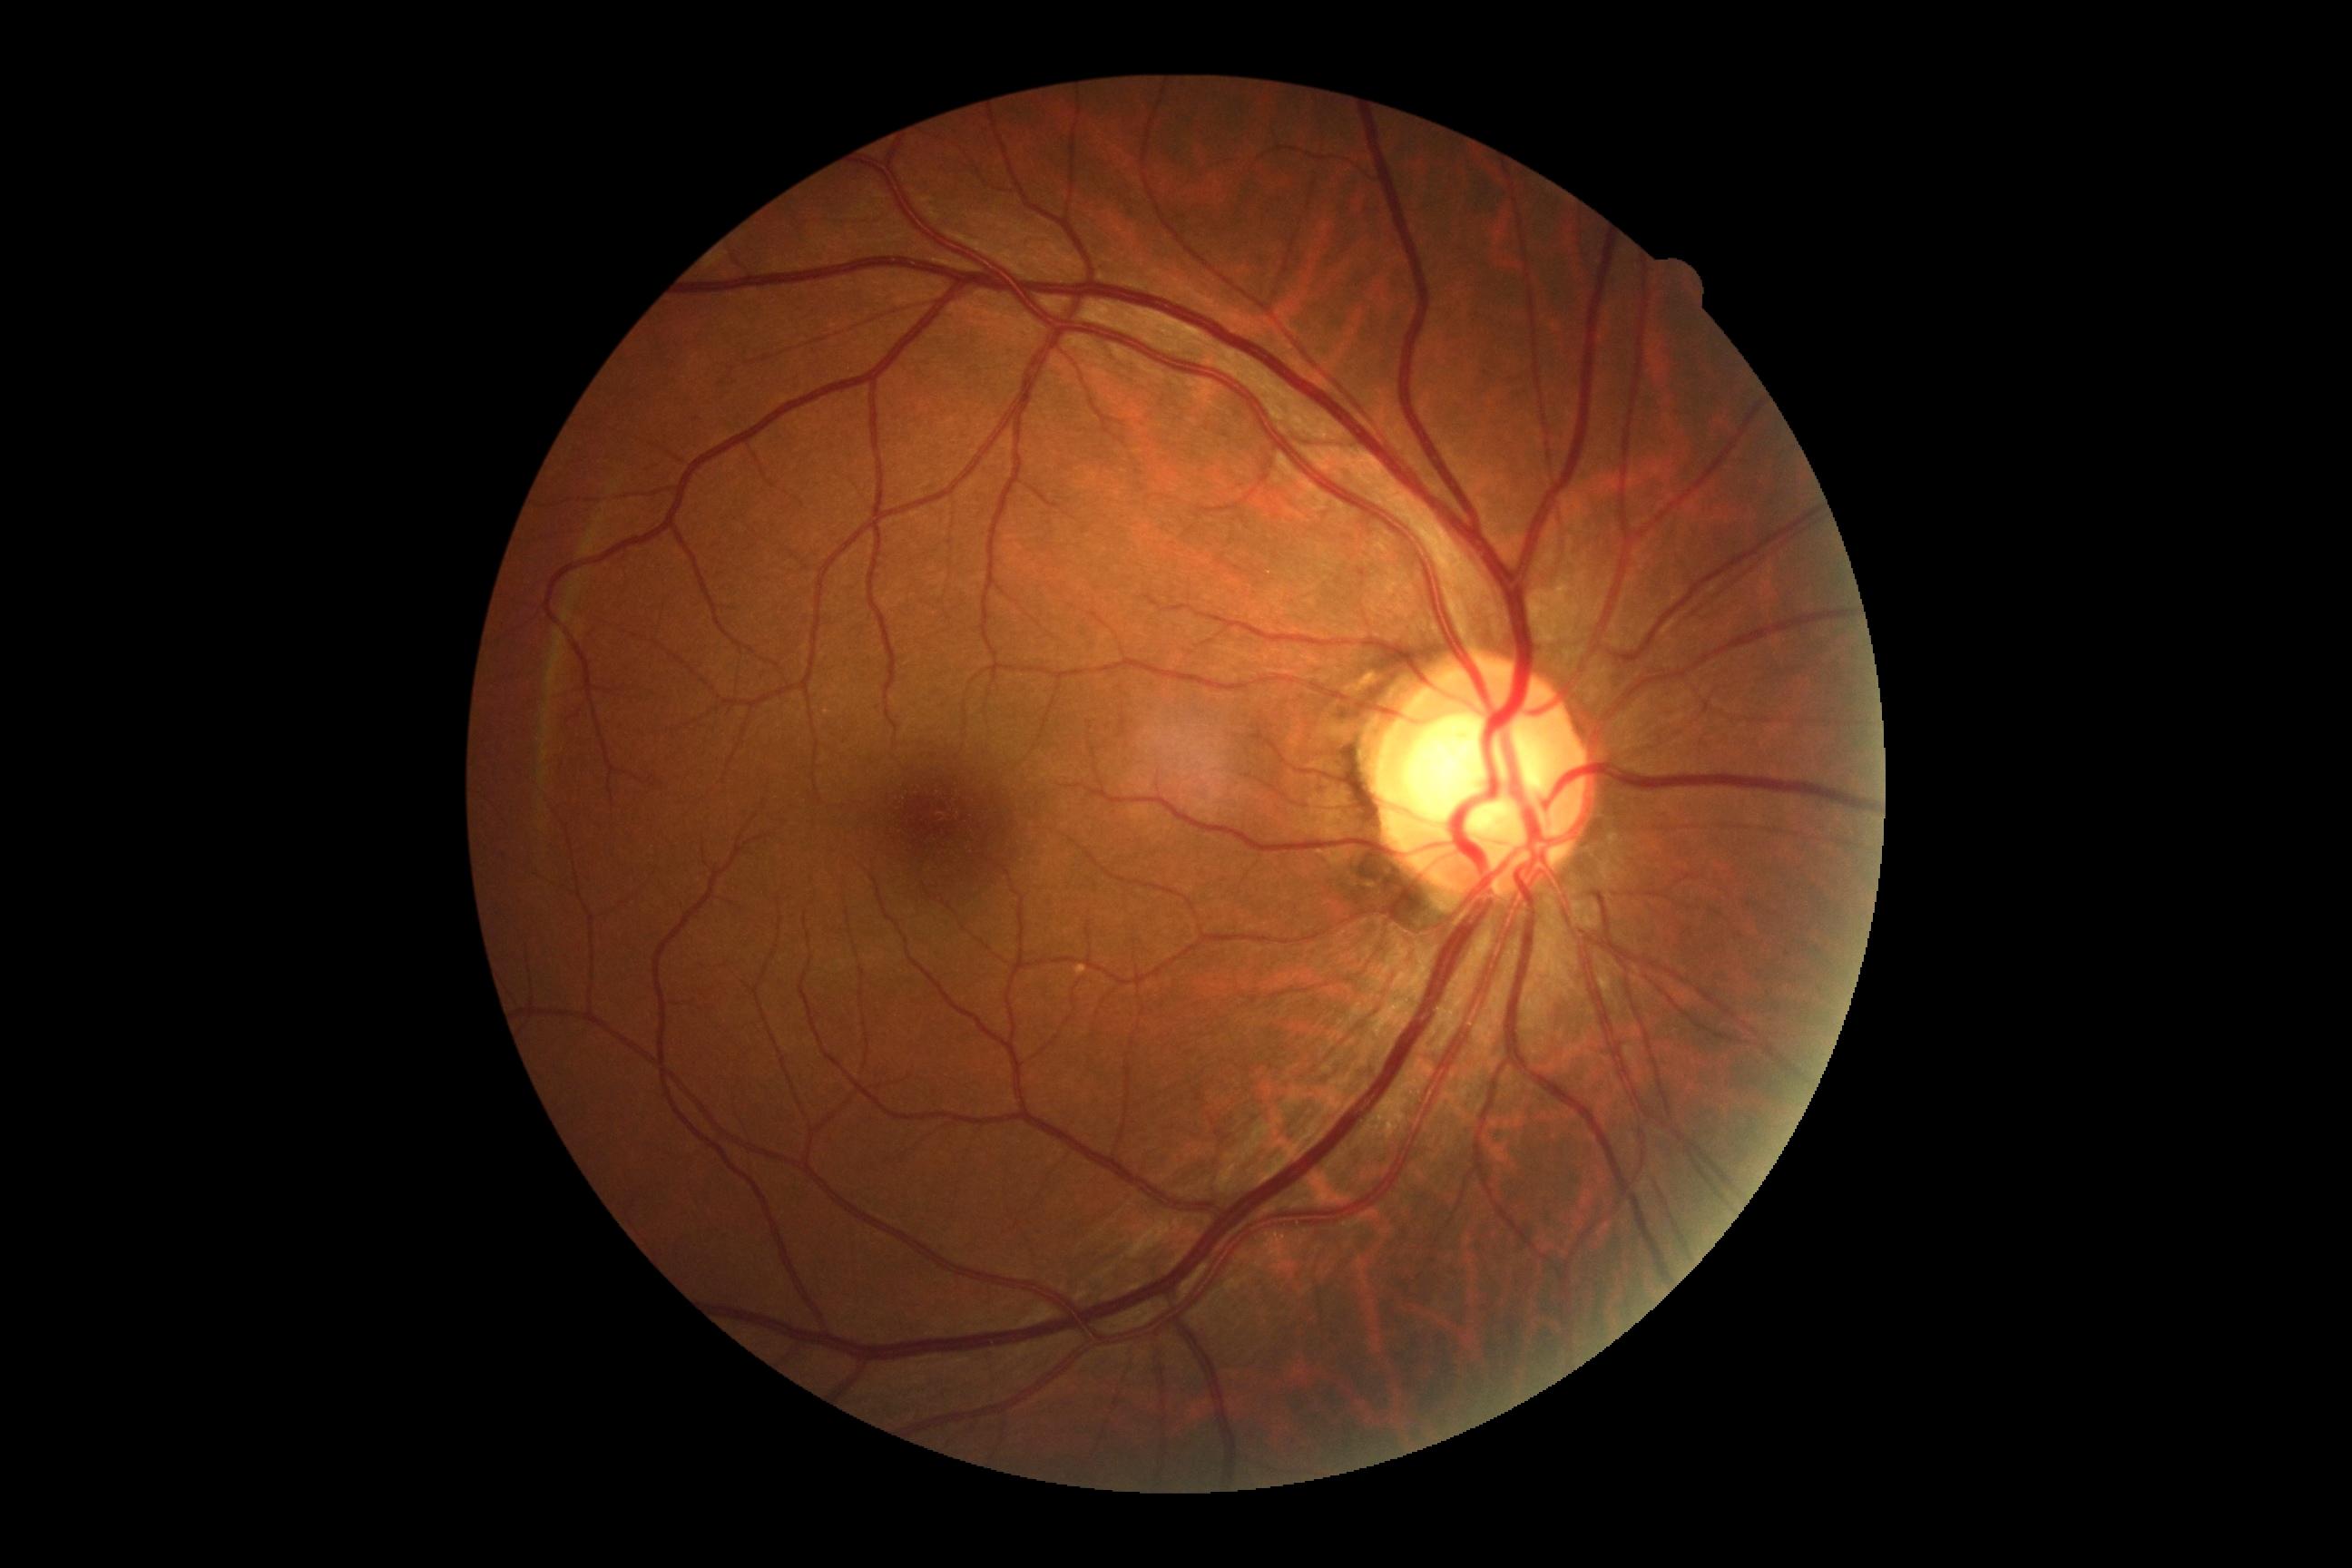
Findings:
– retinopathy grade: no apparent retinopathy (0)